Fundus photo
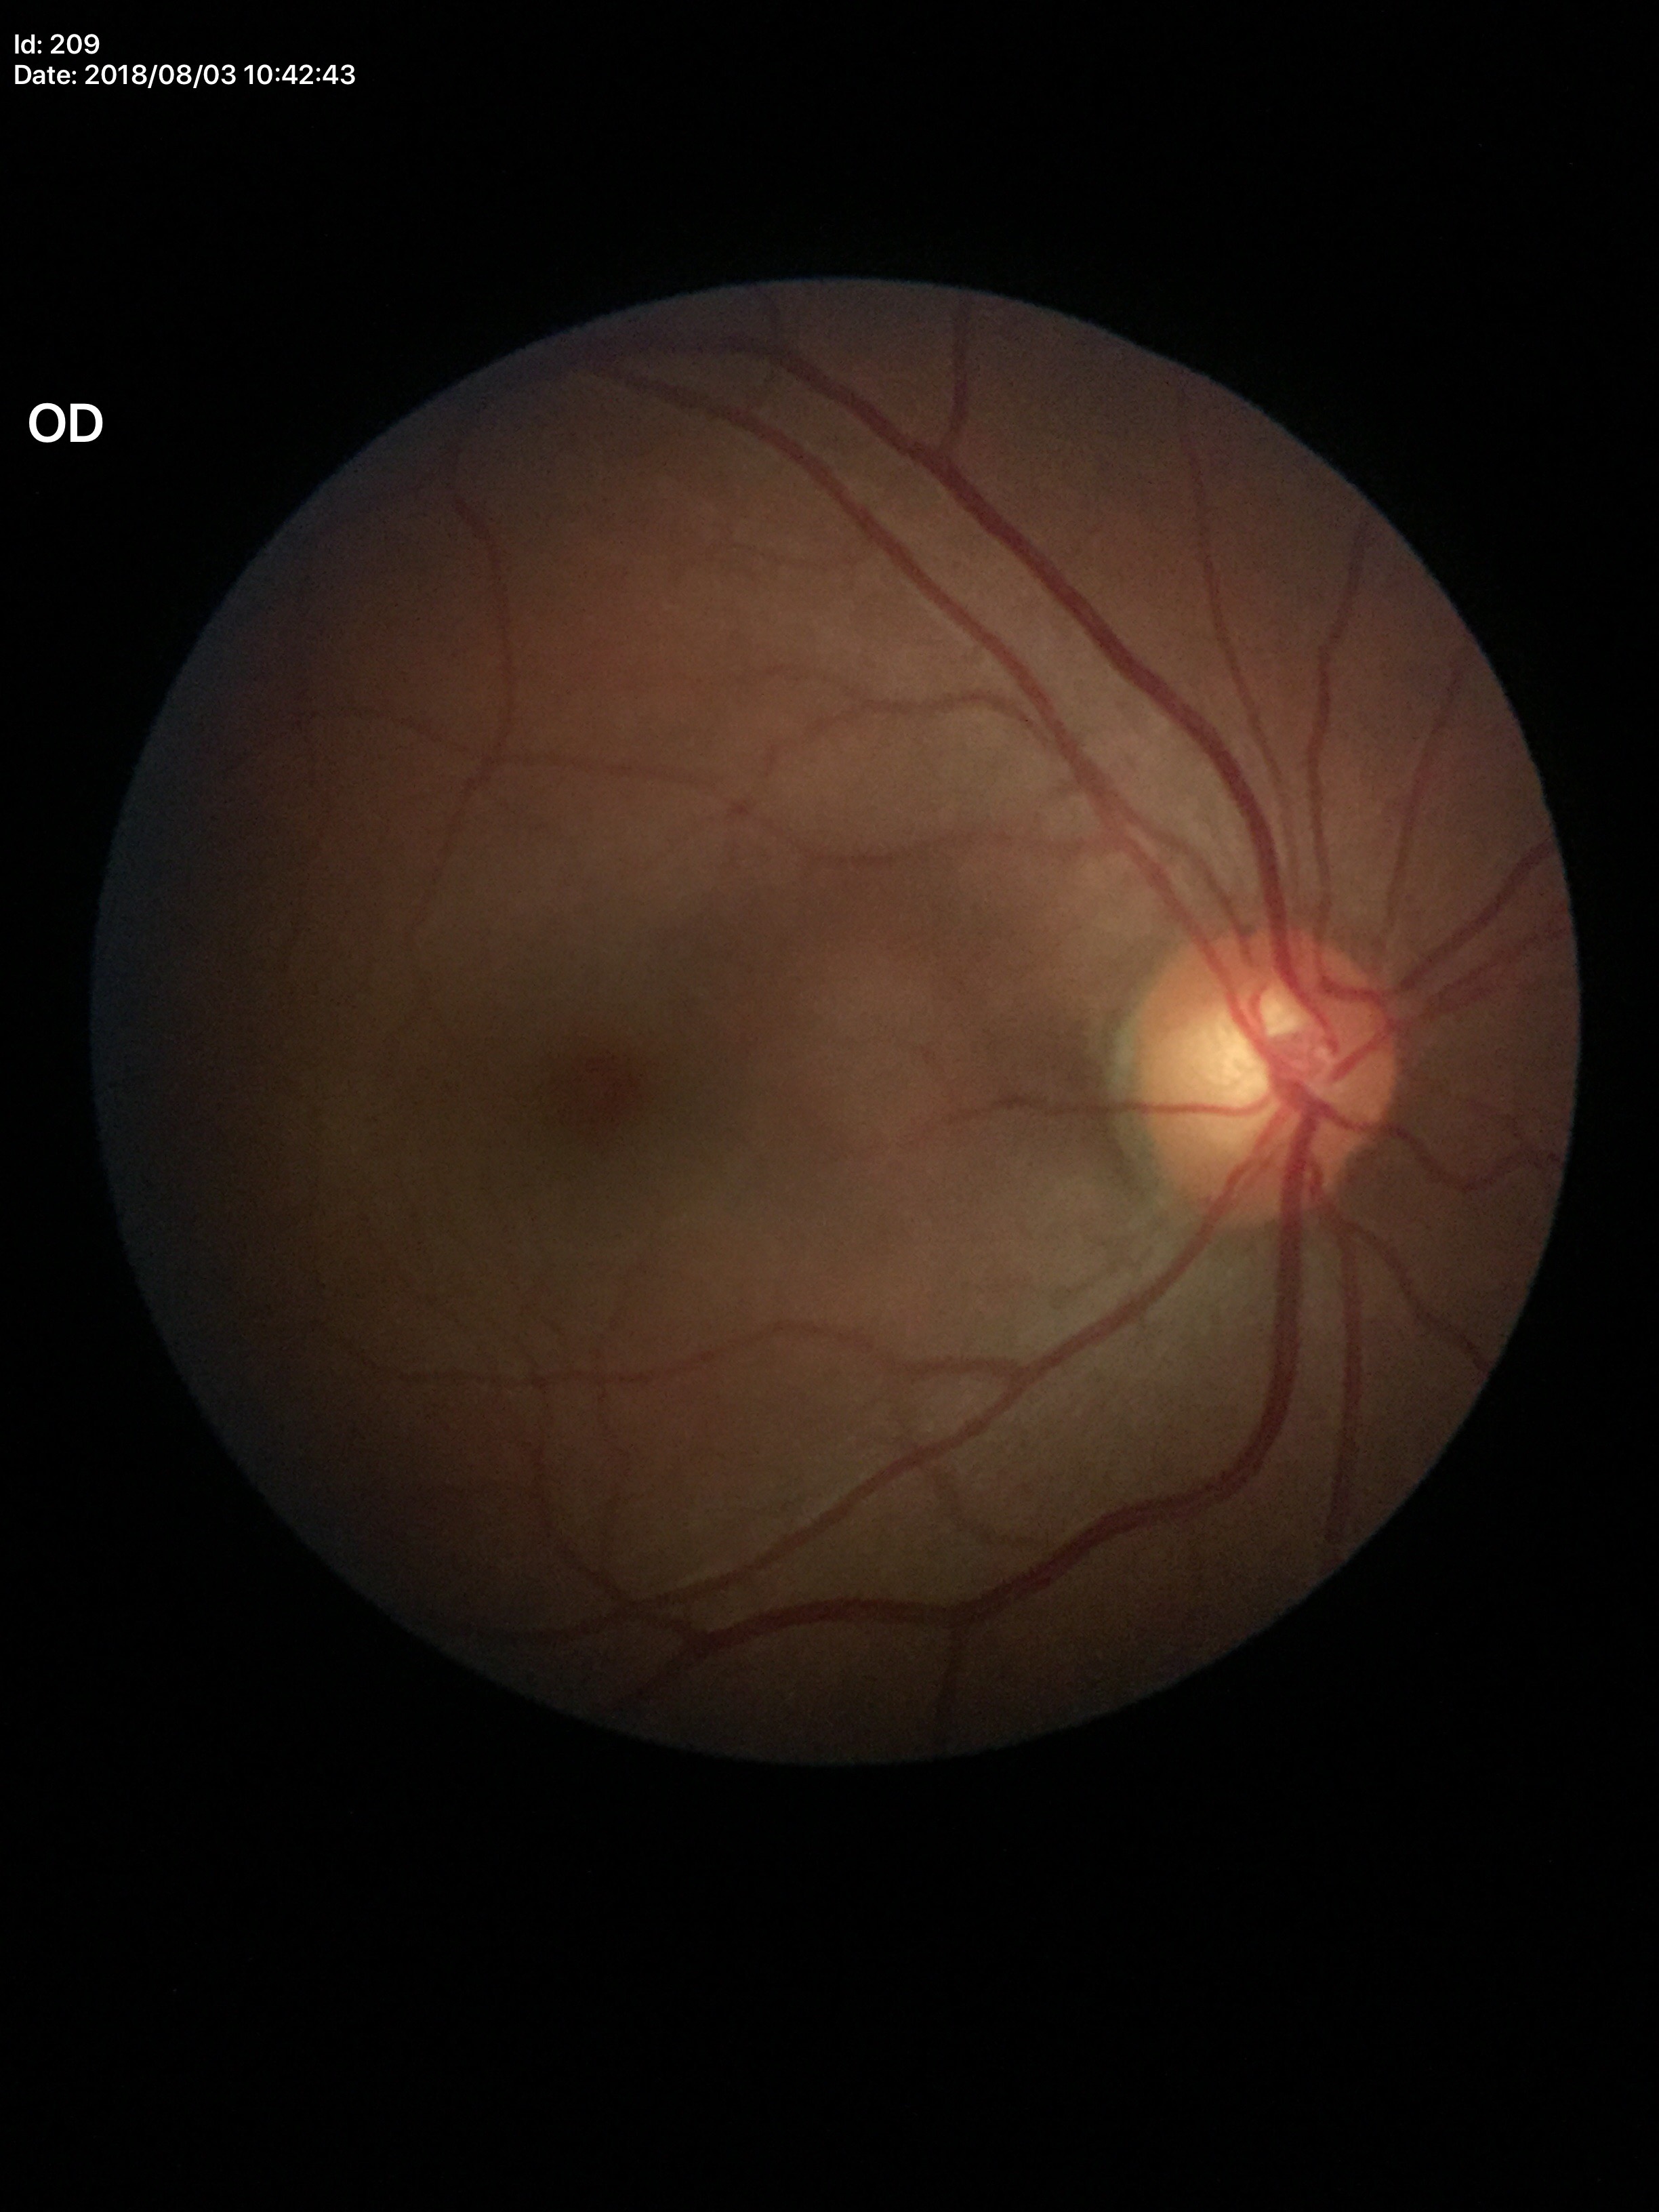 – vertical C/D ratio (VCDR) · 0.59
– area cup-to-disc ratio (ACDR) · 0.33
– Glaucoma decision · no suspicious findings